RetCam wide-field infant fundus image. 130° field of view (Natus RetCam Envision).
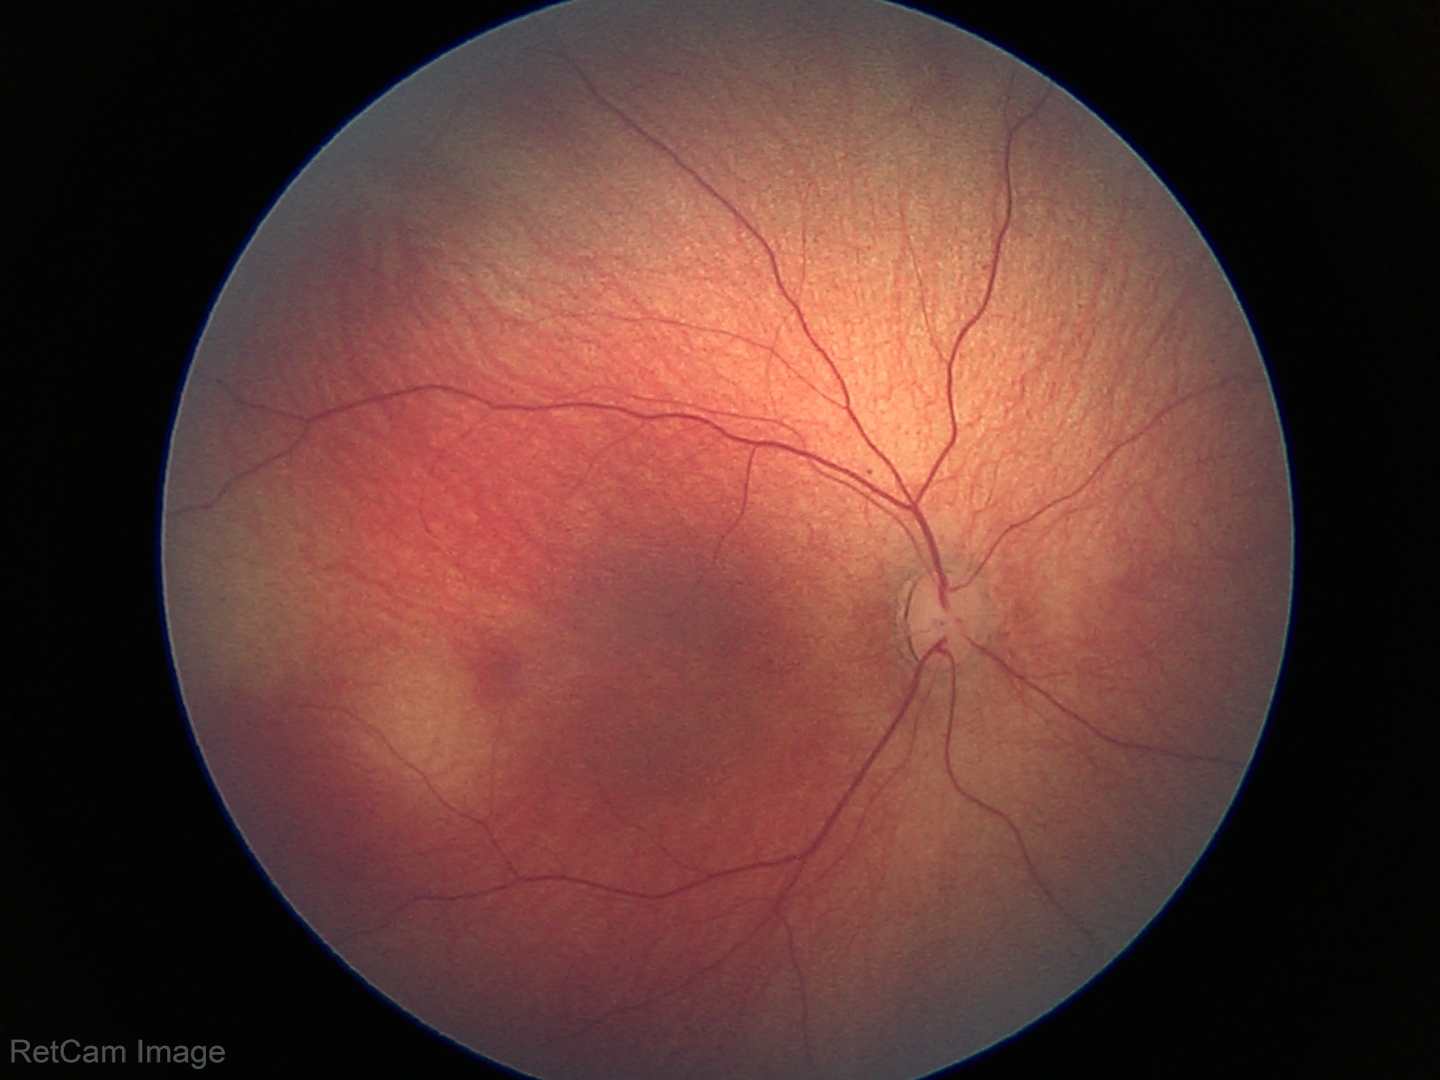
Assessment: physiological retinal finding.